848 by 848 pixels; 45° field of view
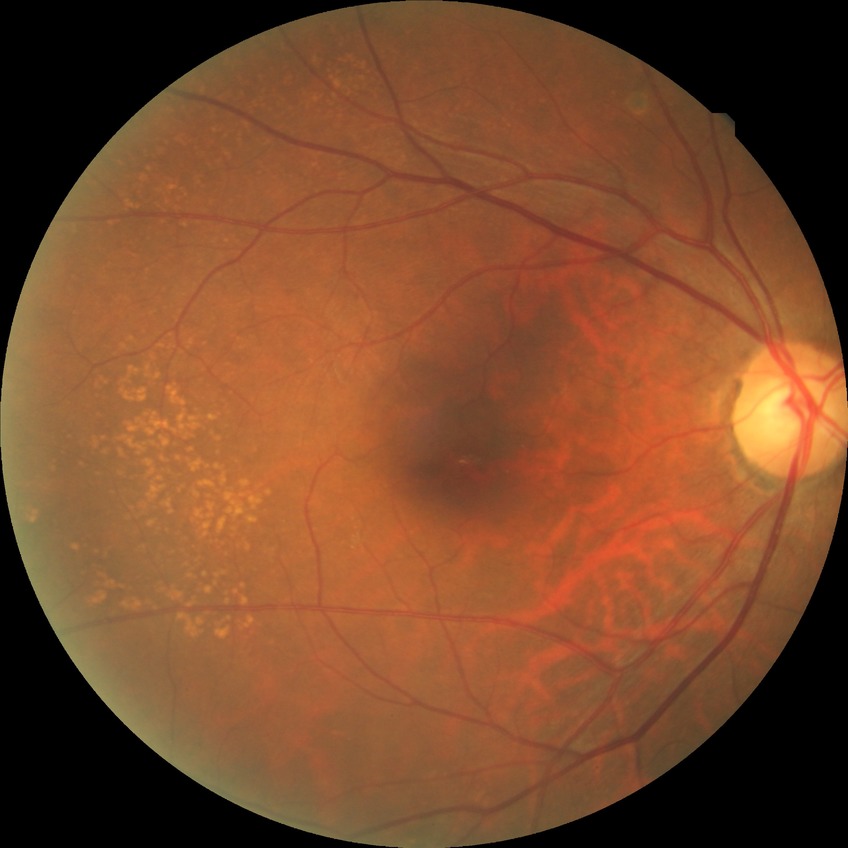

{
  "davis_grade": "NDR (no diabetic retinopathy)"
}